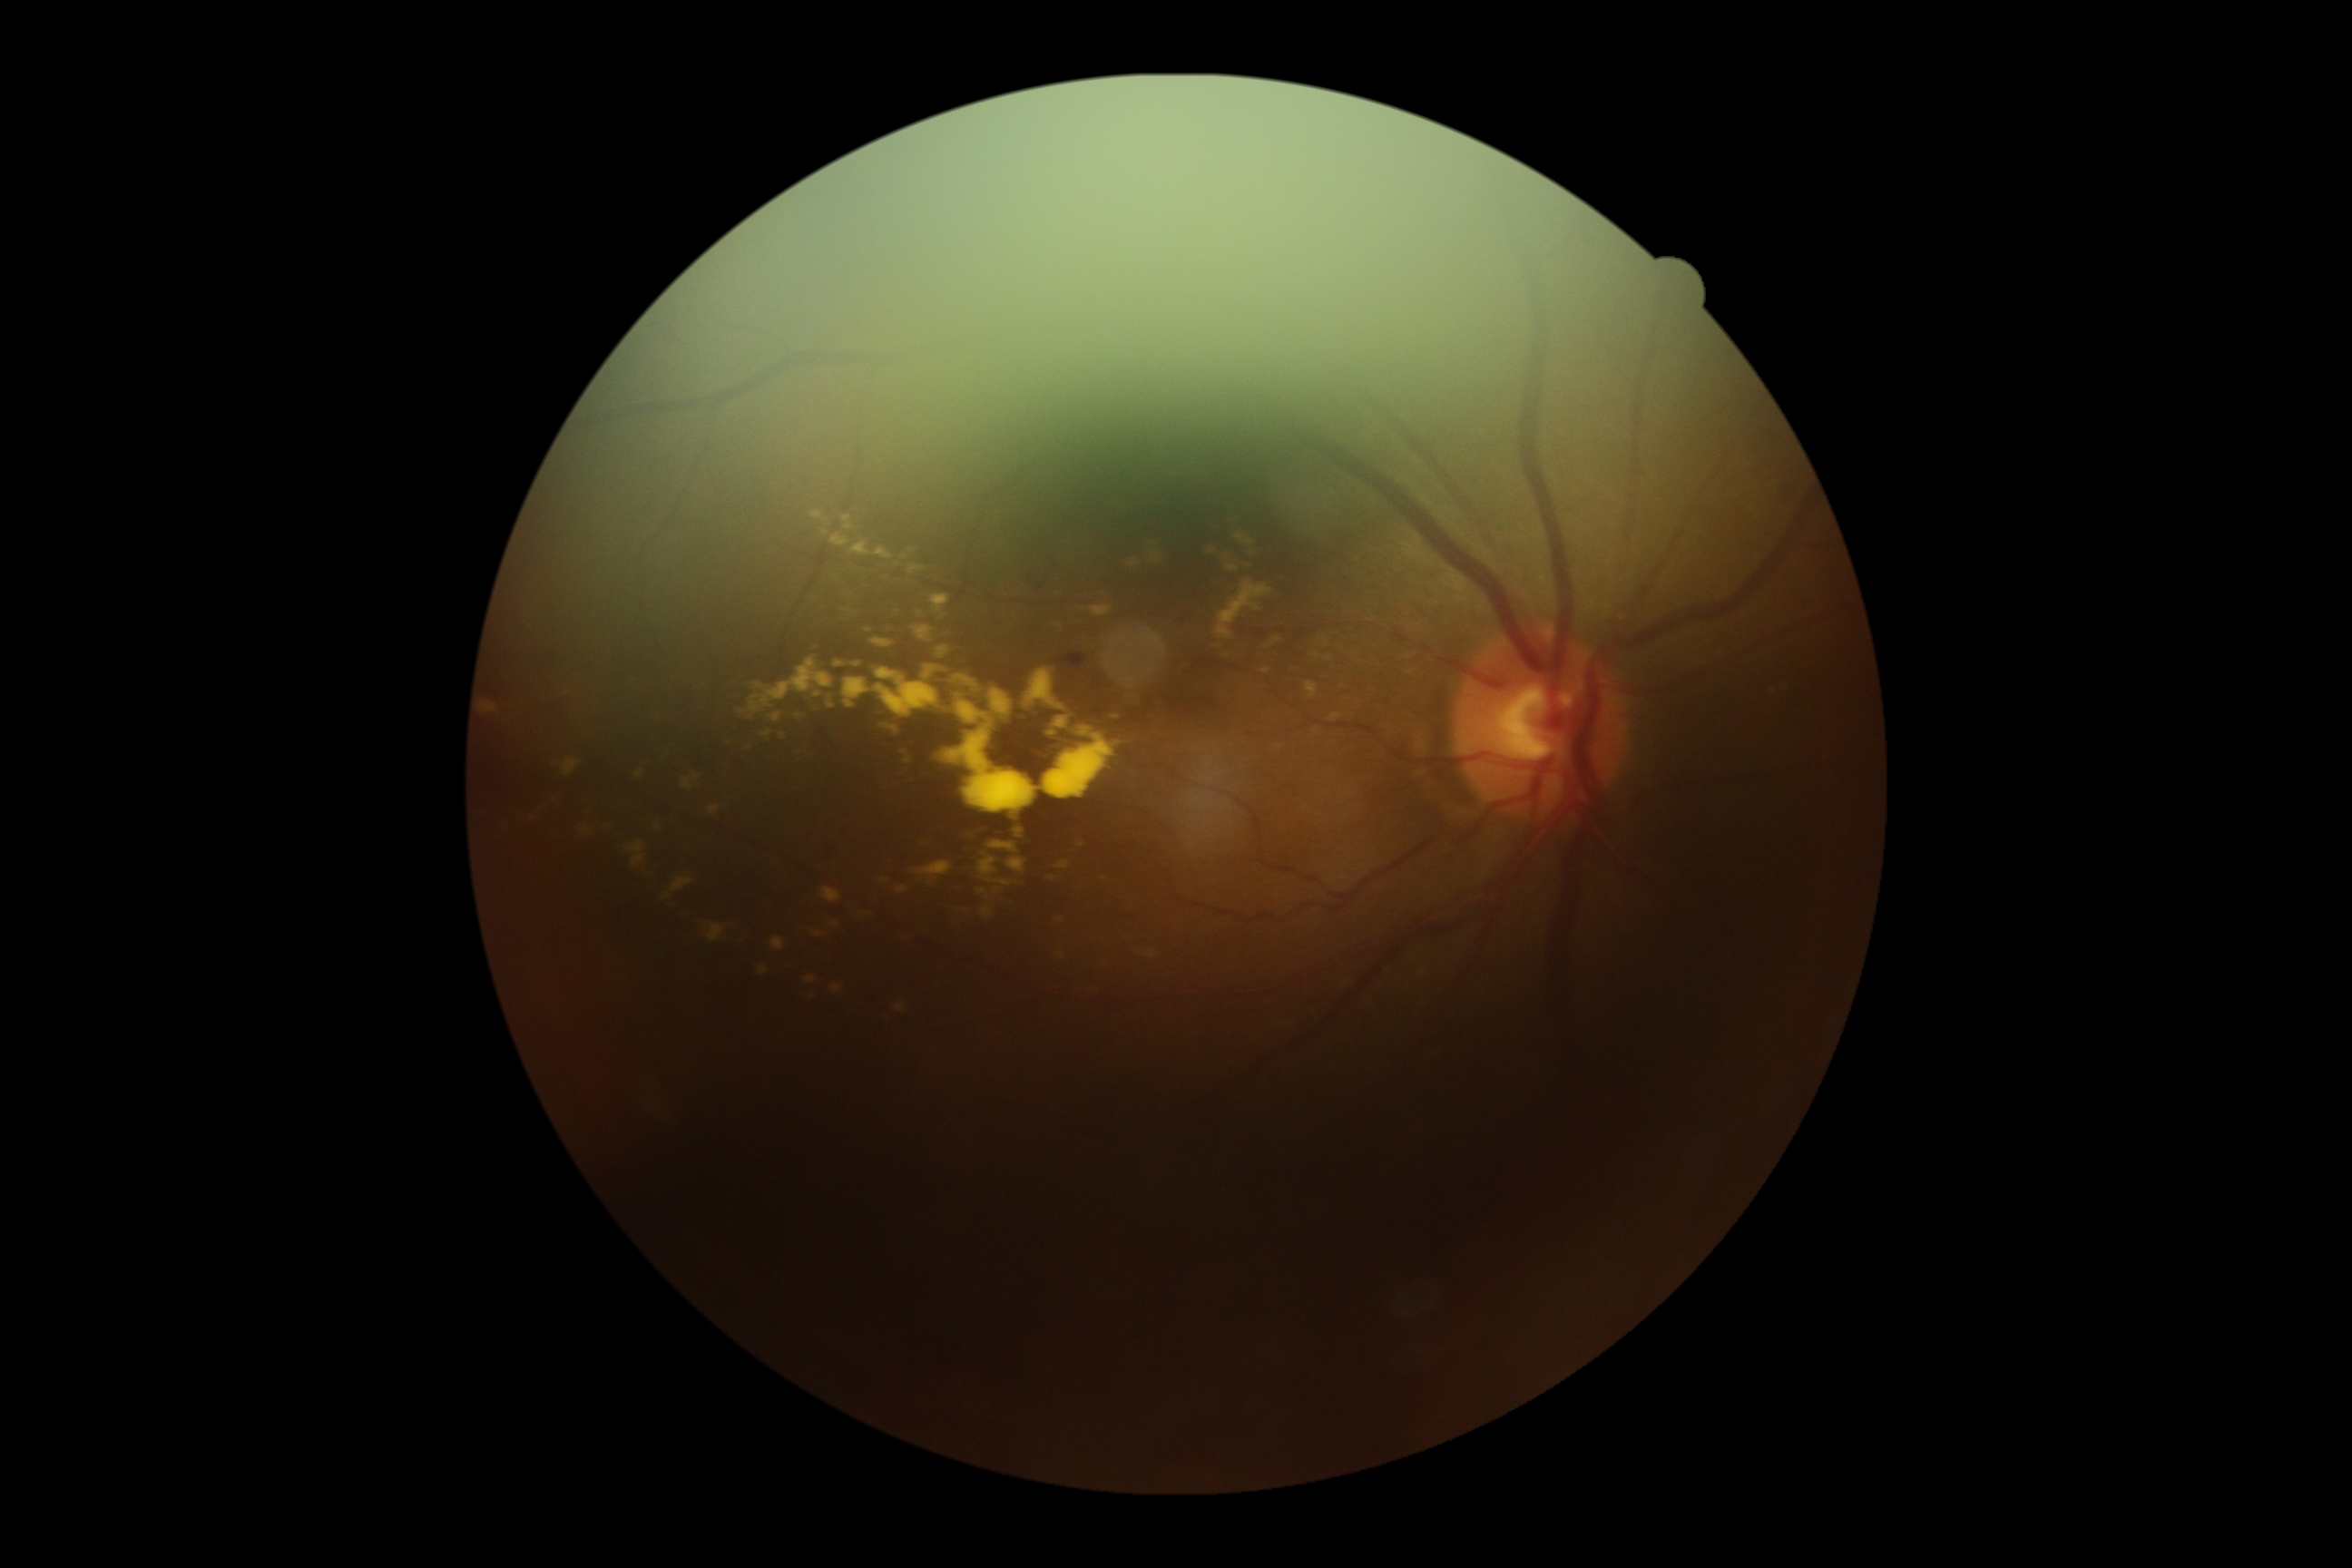 diabetic retinopathy (DR): 2.